Image size 2048x1536.
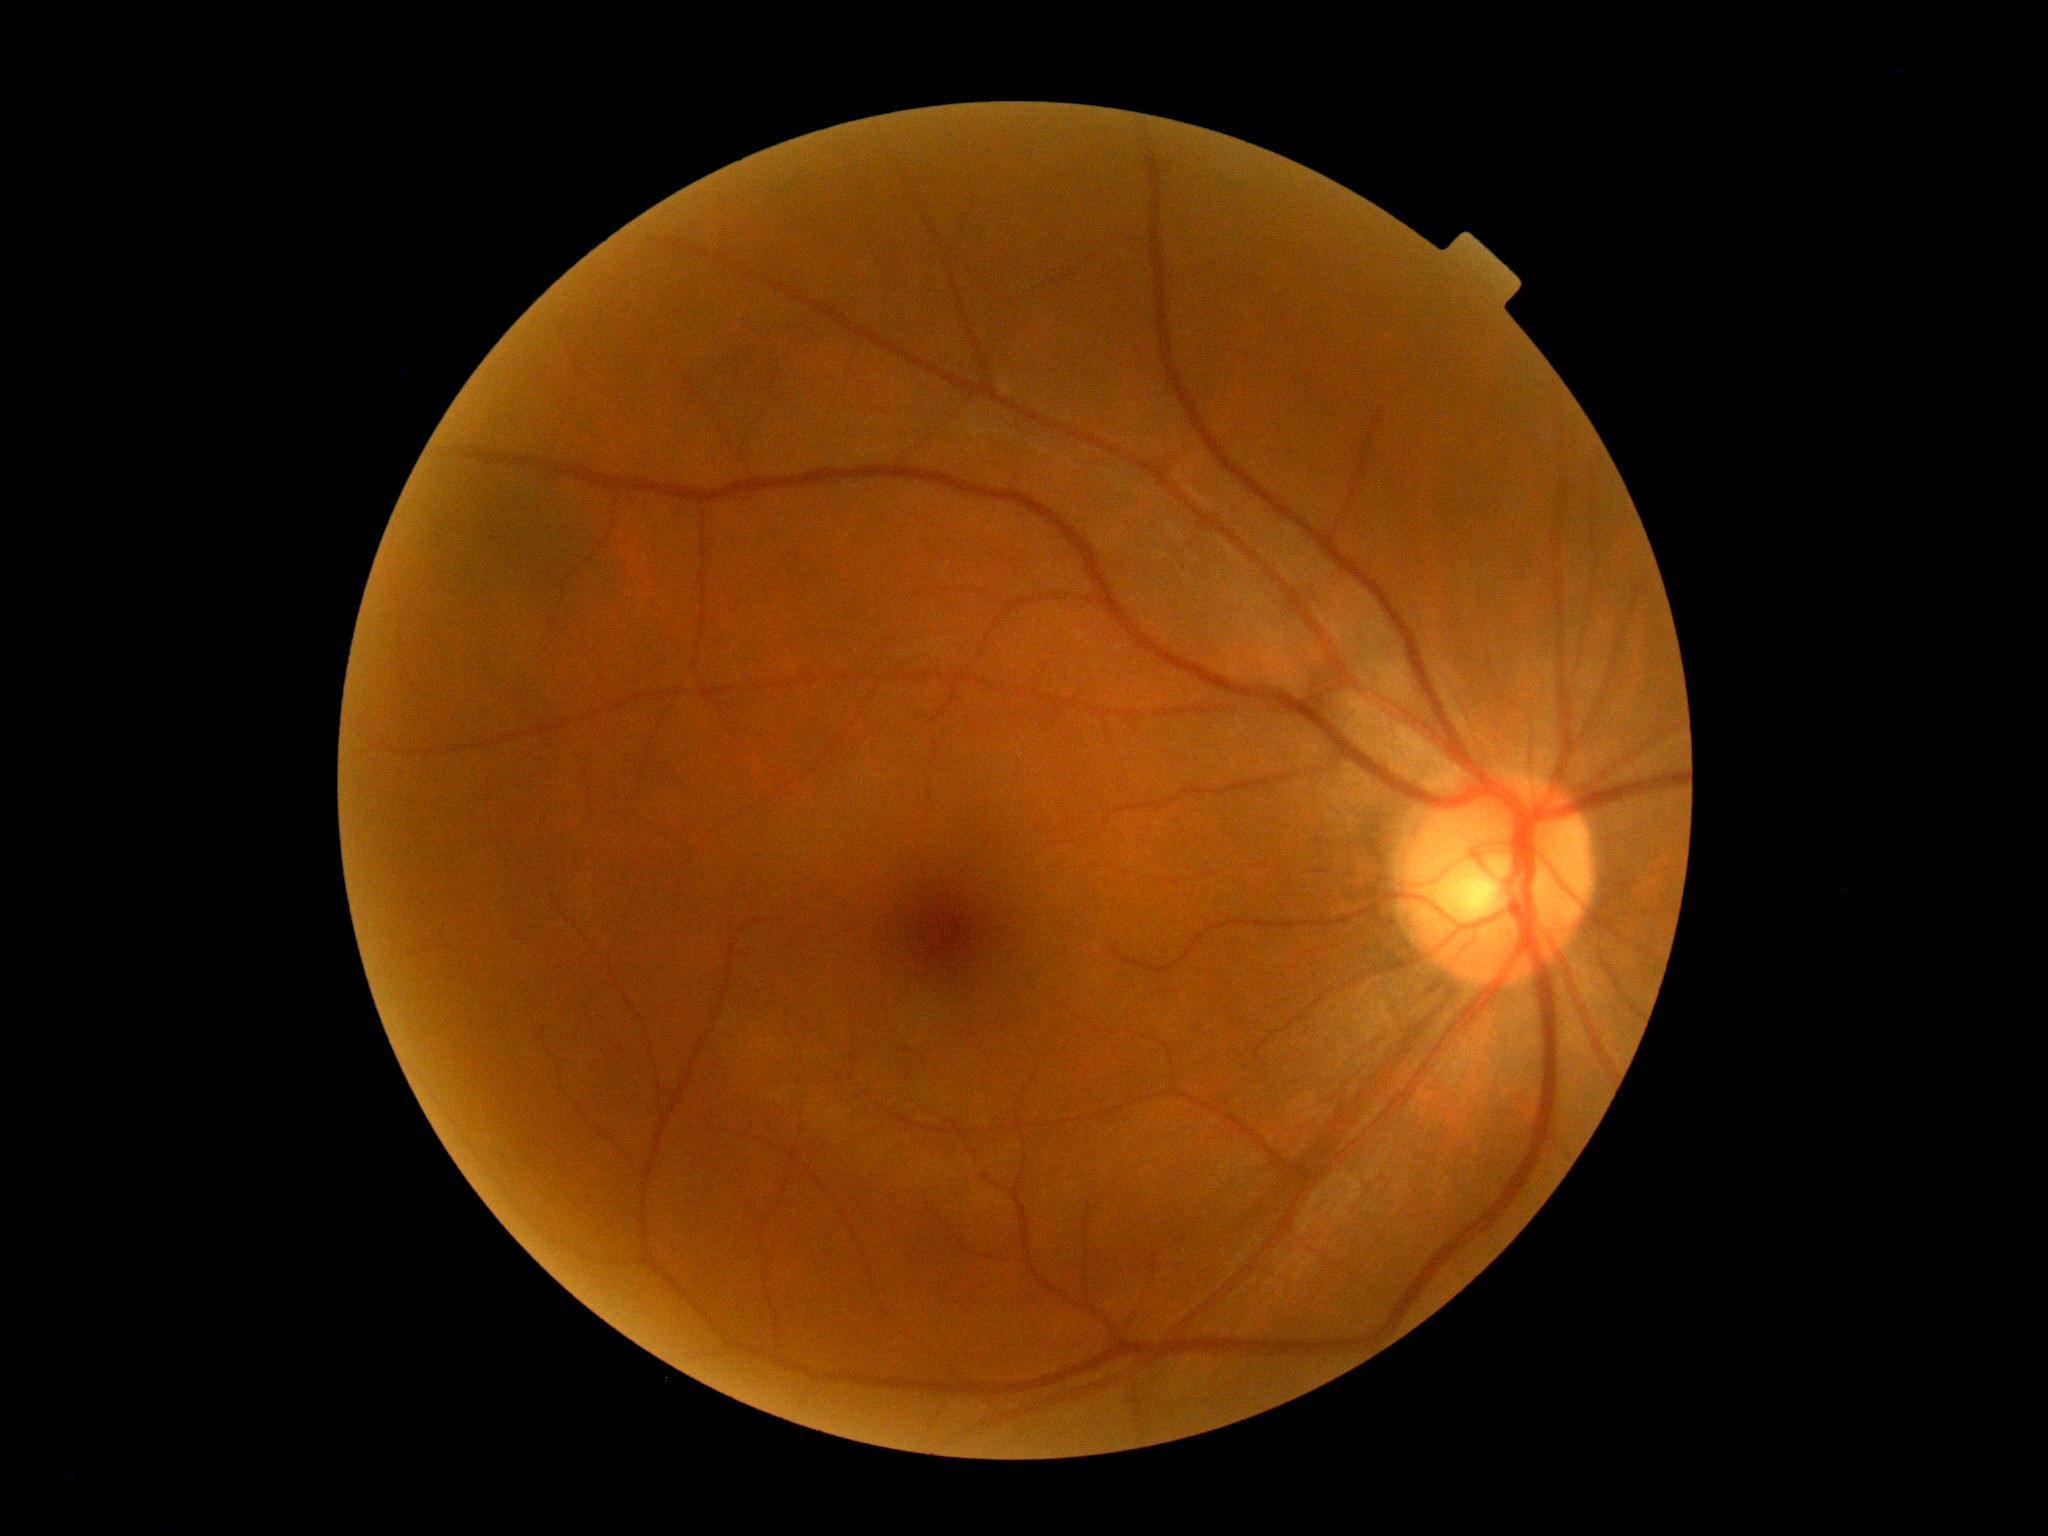

- DR — grade 0 (no apparent retinopathy)